45° field of view; 2048x1536px
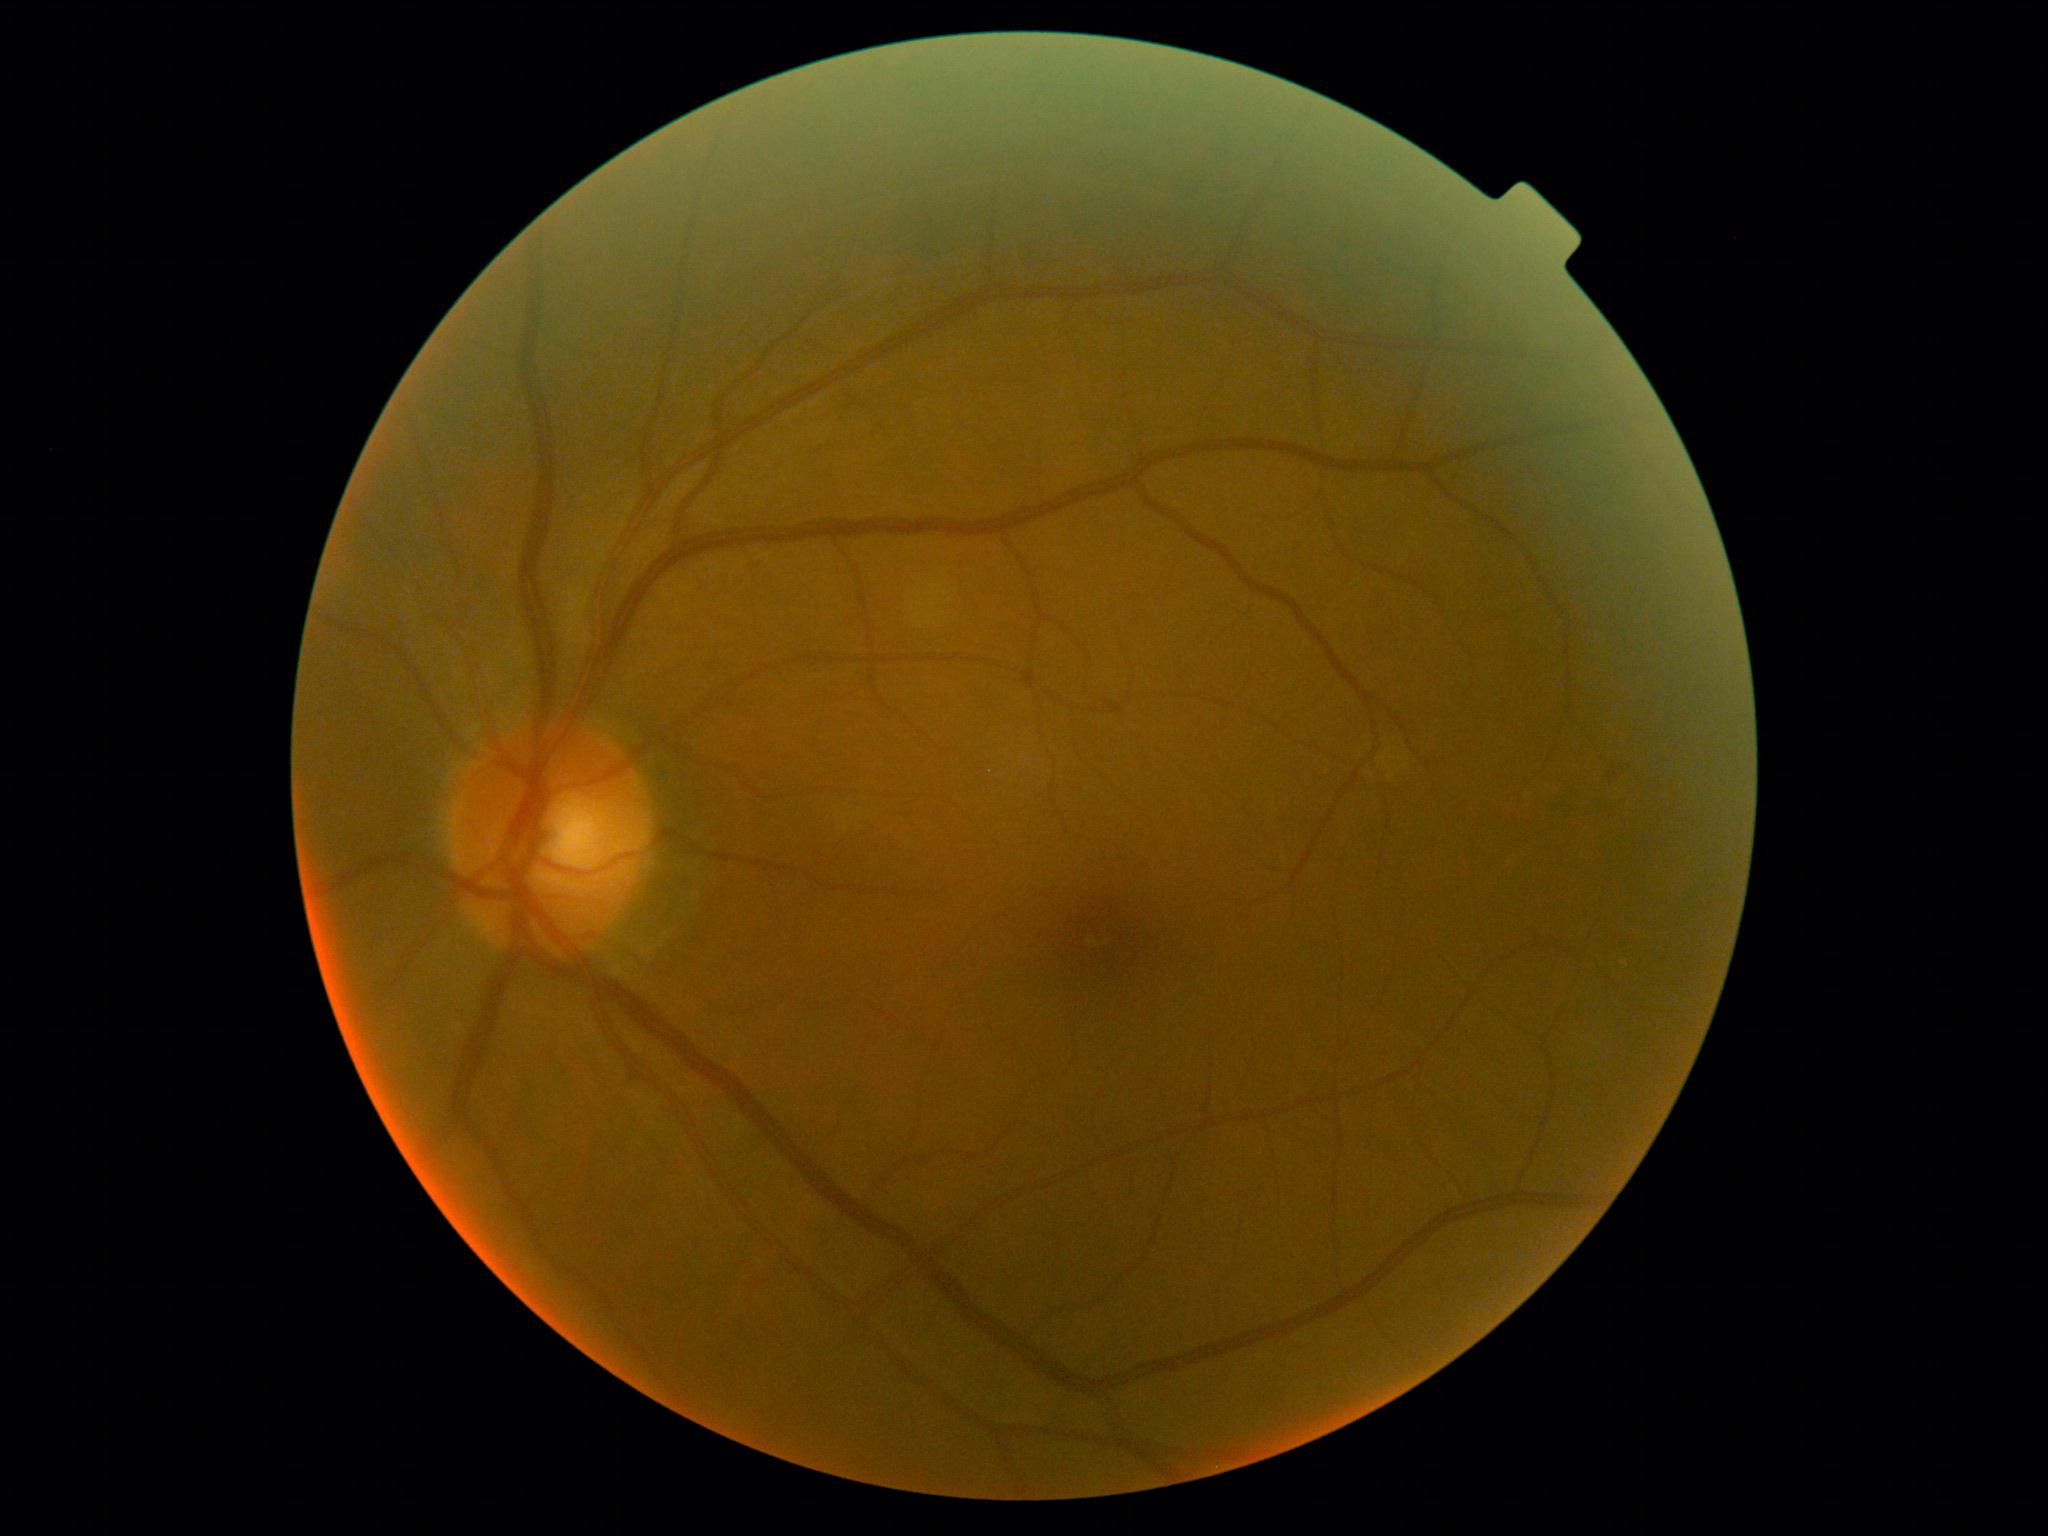 DR stage: 1